Image size 1659x2212.
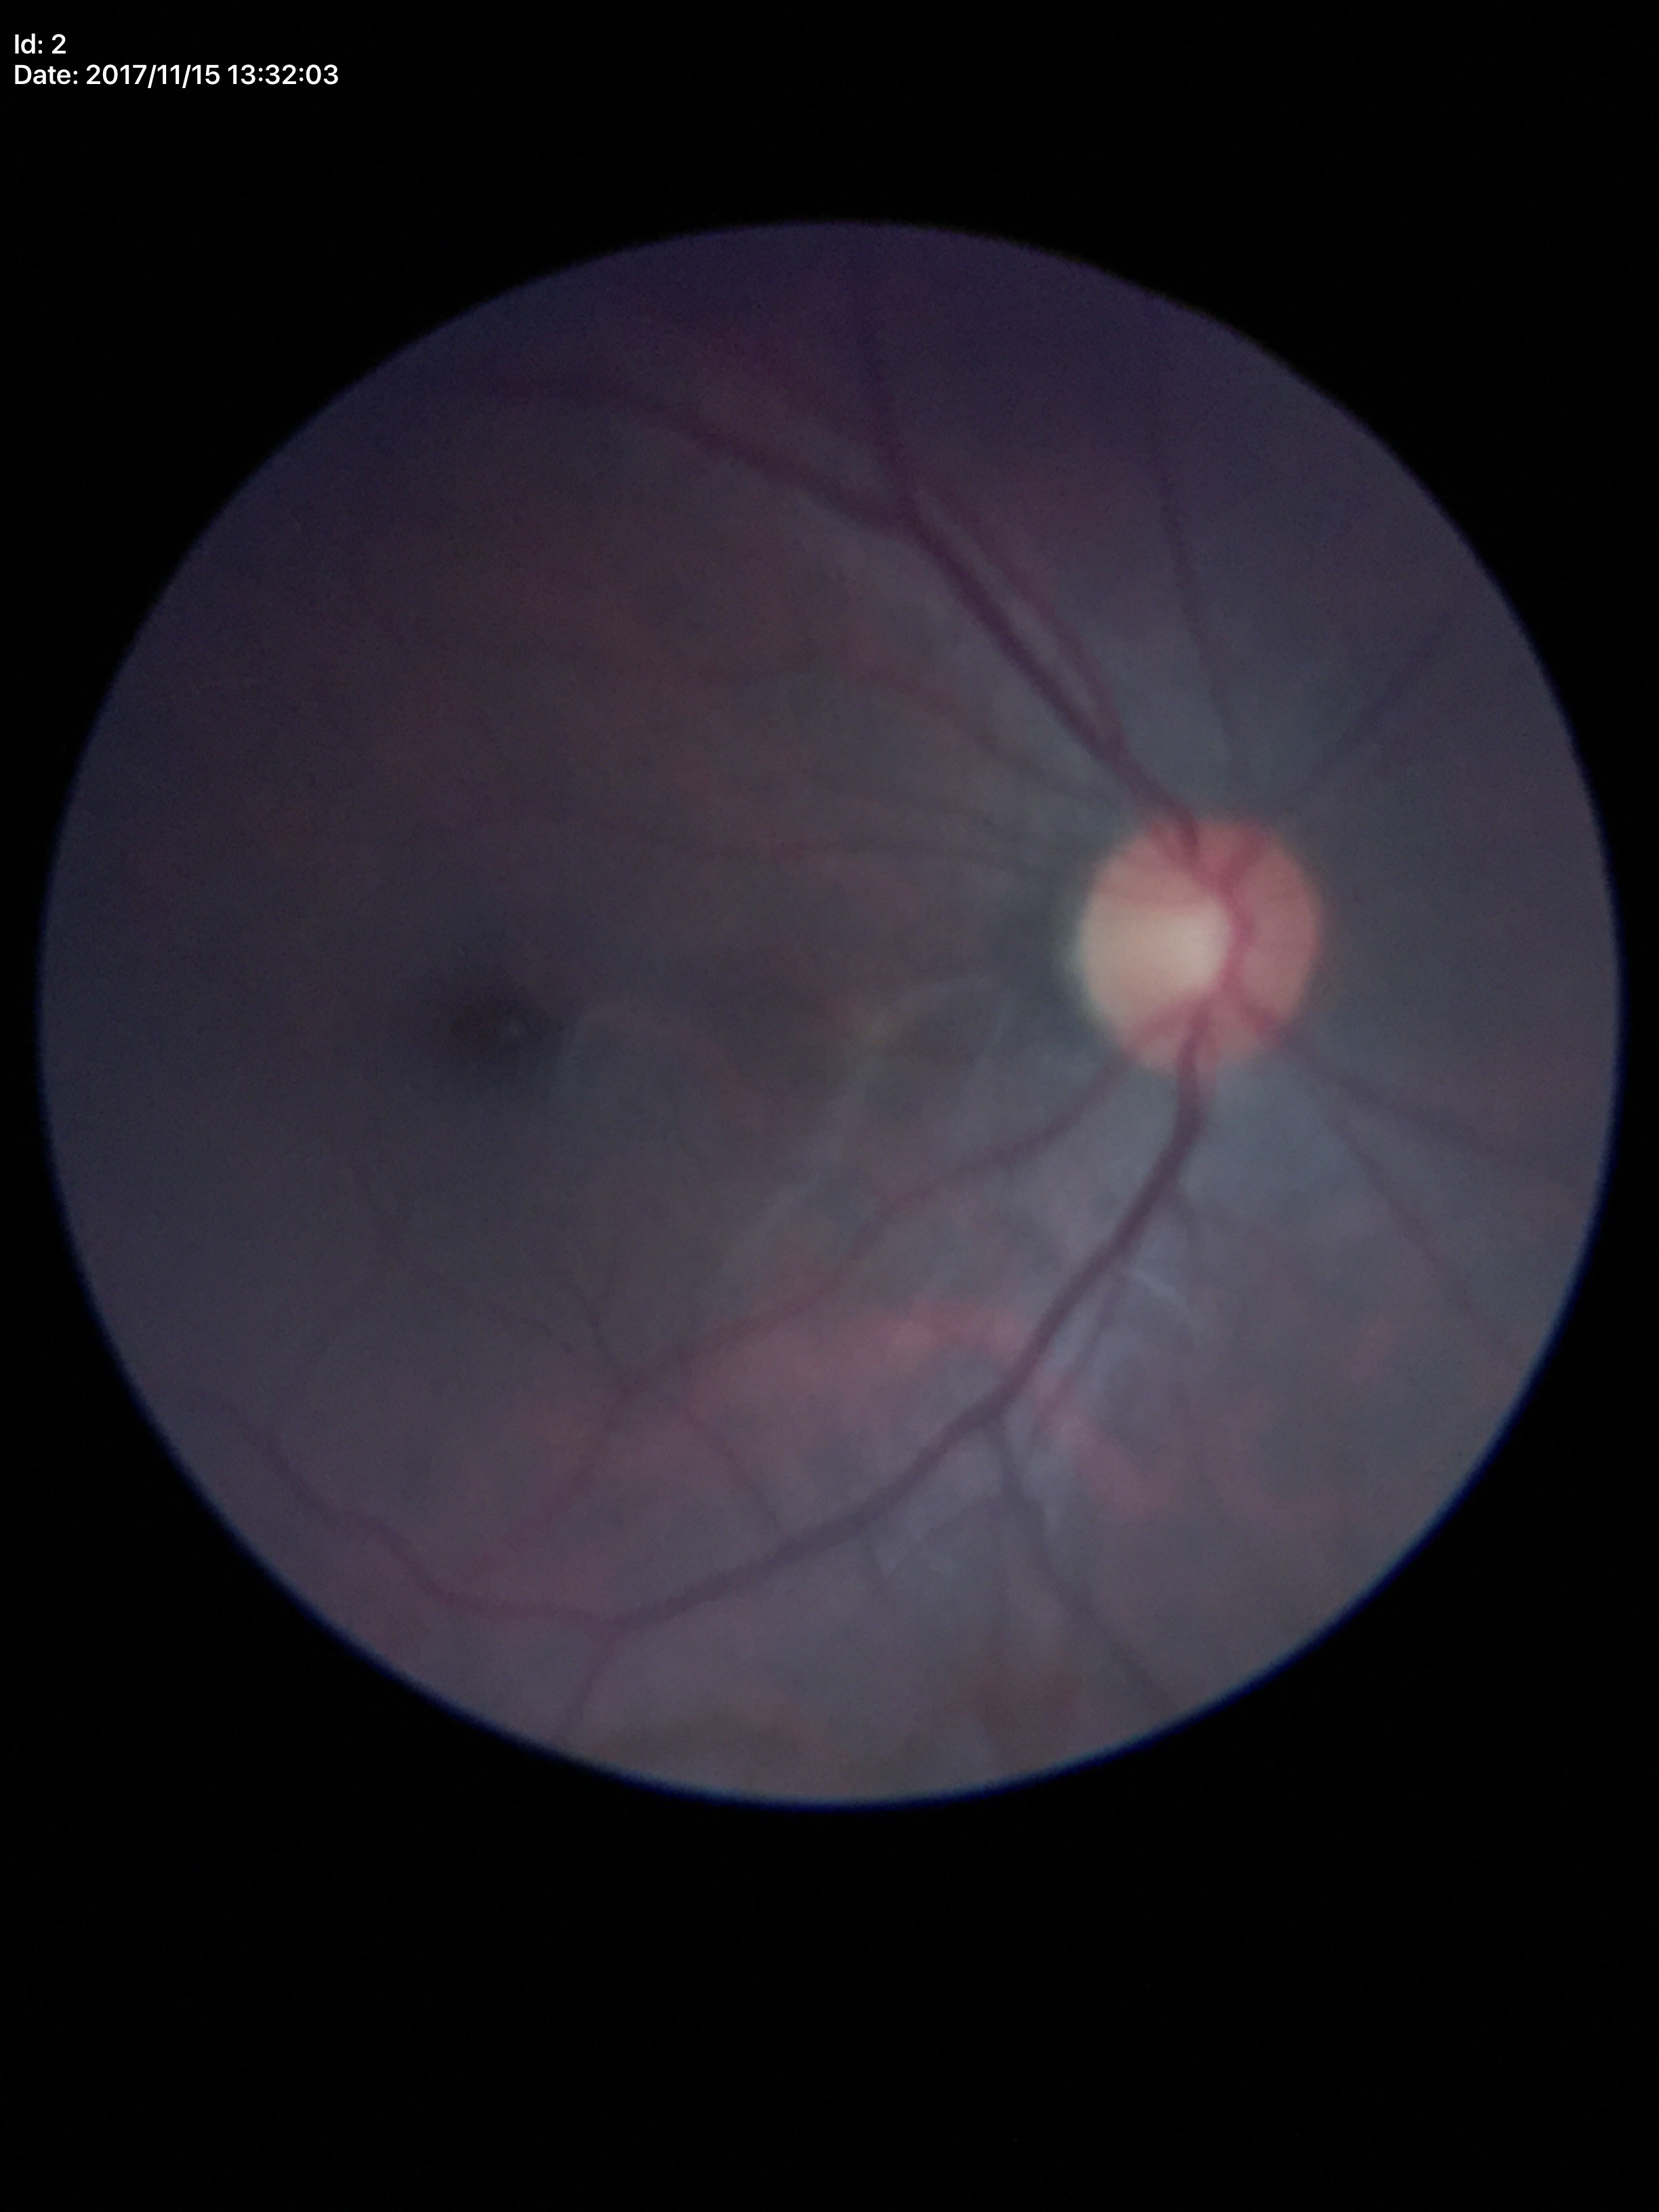 Q: What is the glaucoma assessment?
A: not suspect
Q: What is the horizontal cup-to-disc ratio?
A: 0.51
Q: What is the VCDR?
A: 0.52